848x848
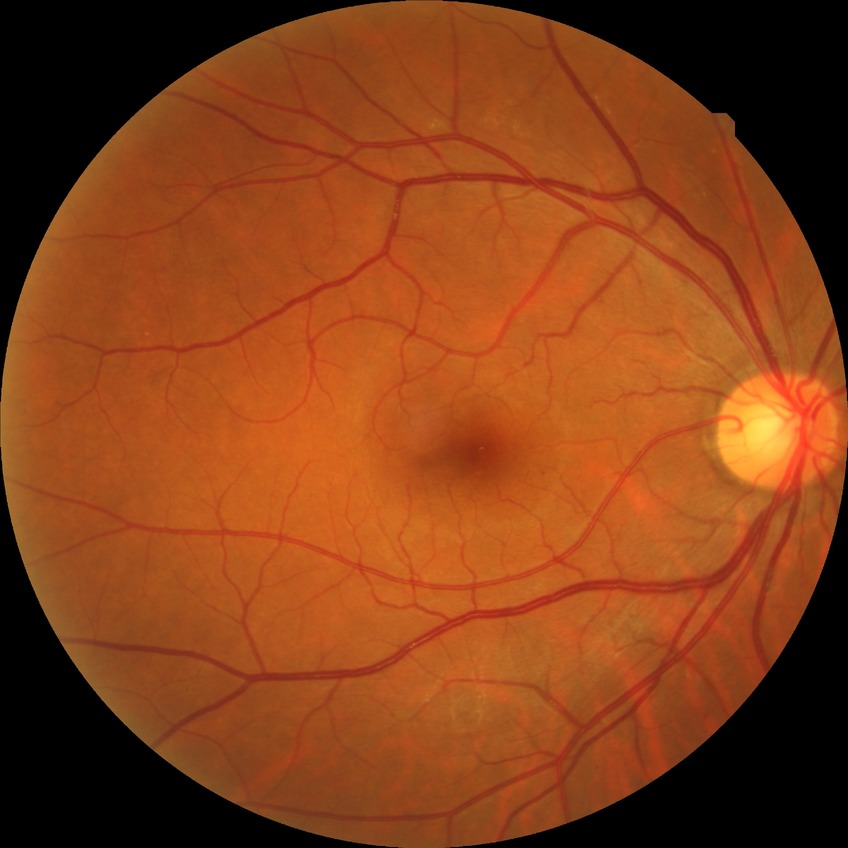 Diabetic retinopathy severity is no diabetic retinopathy.